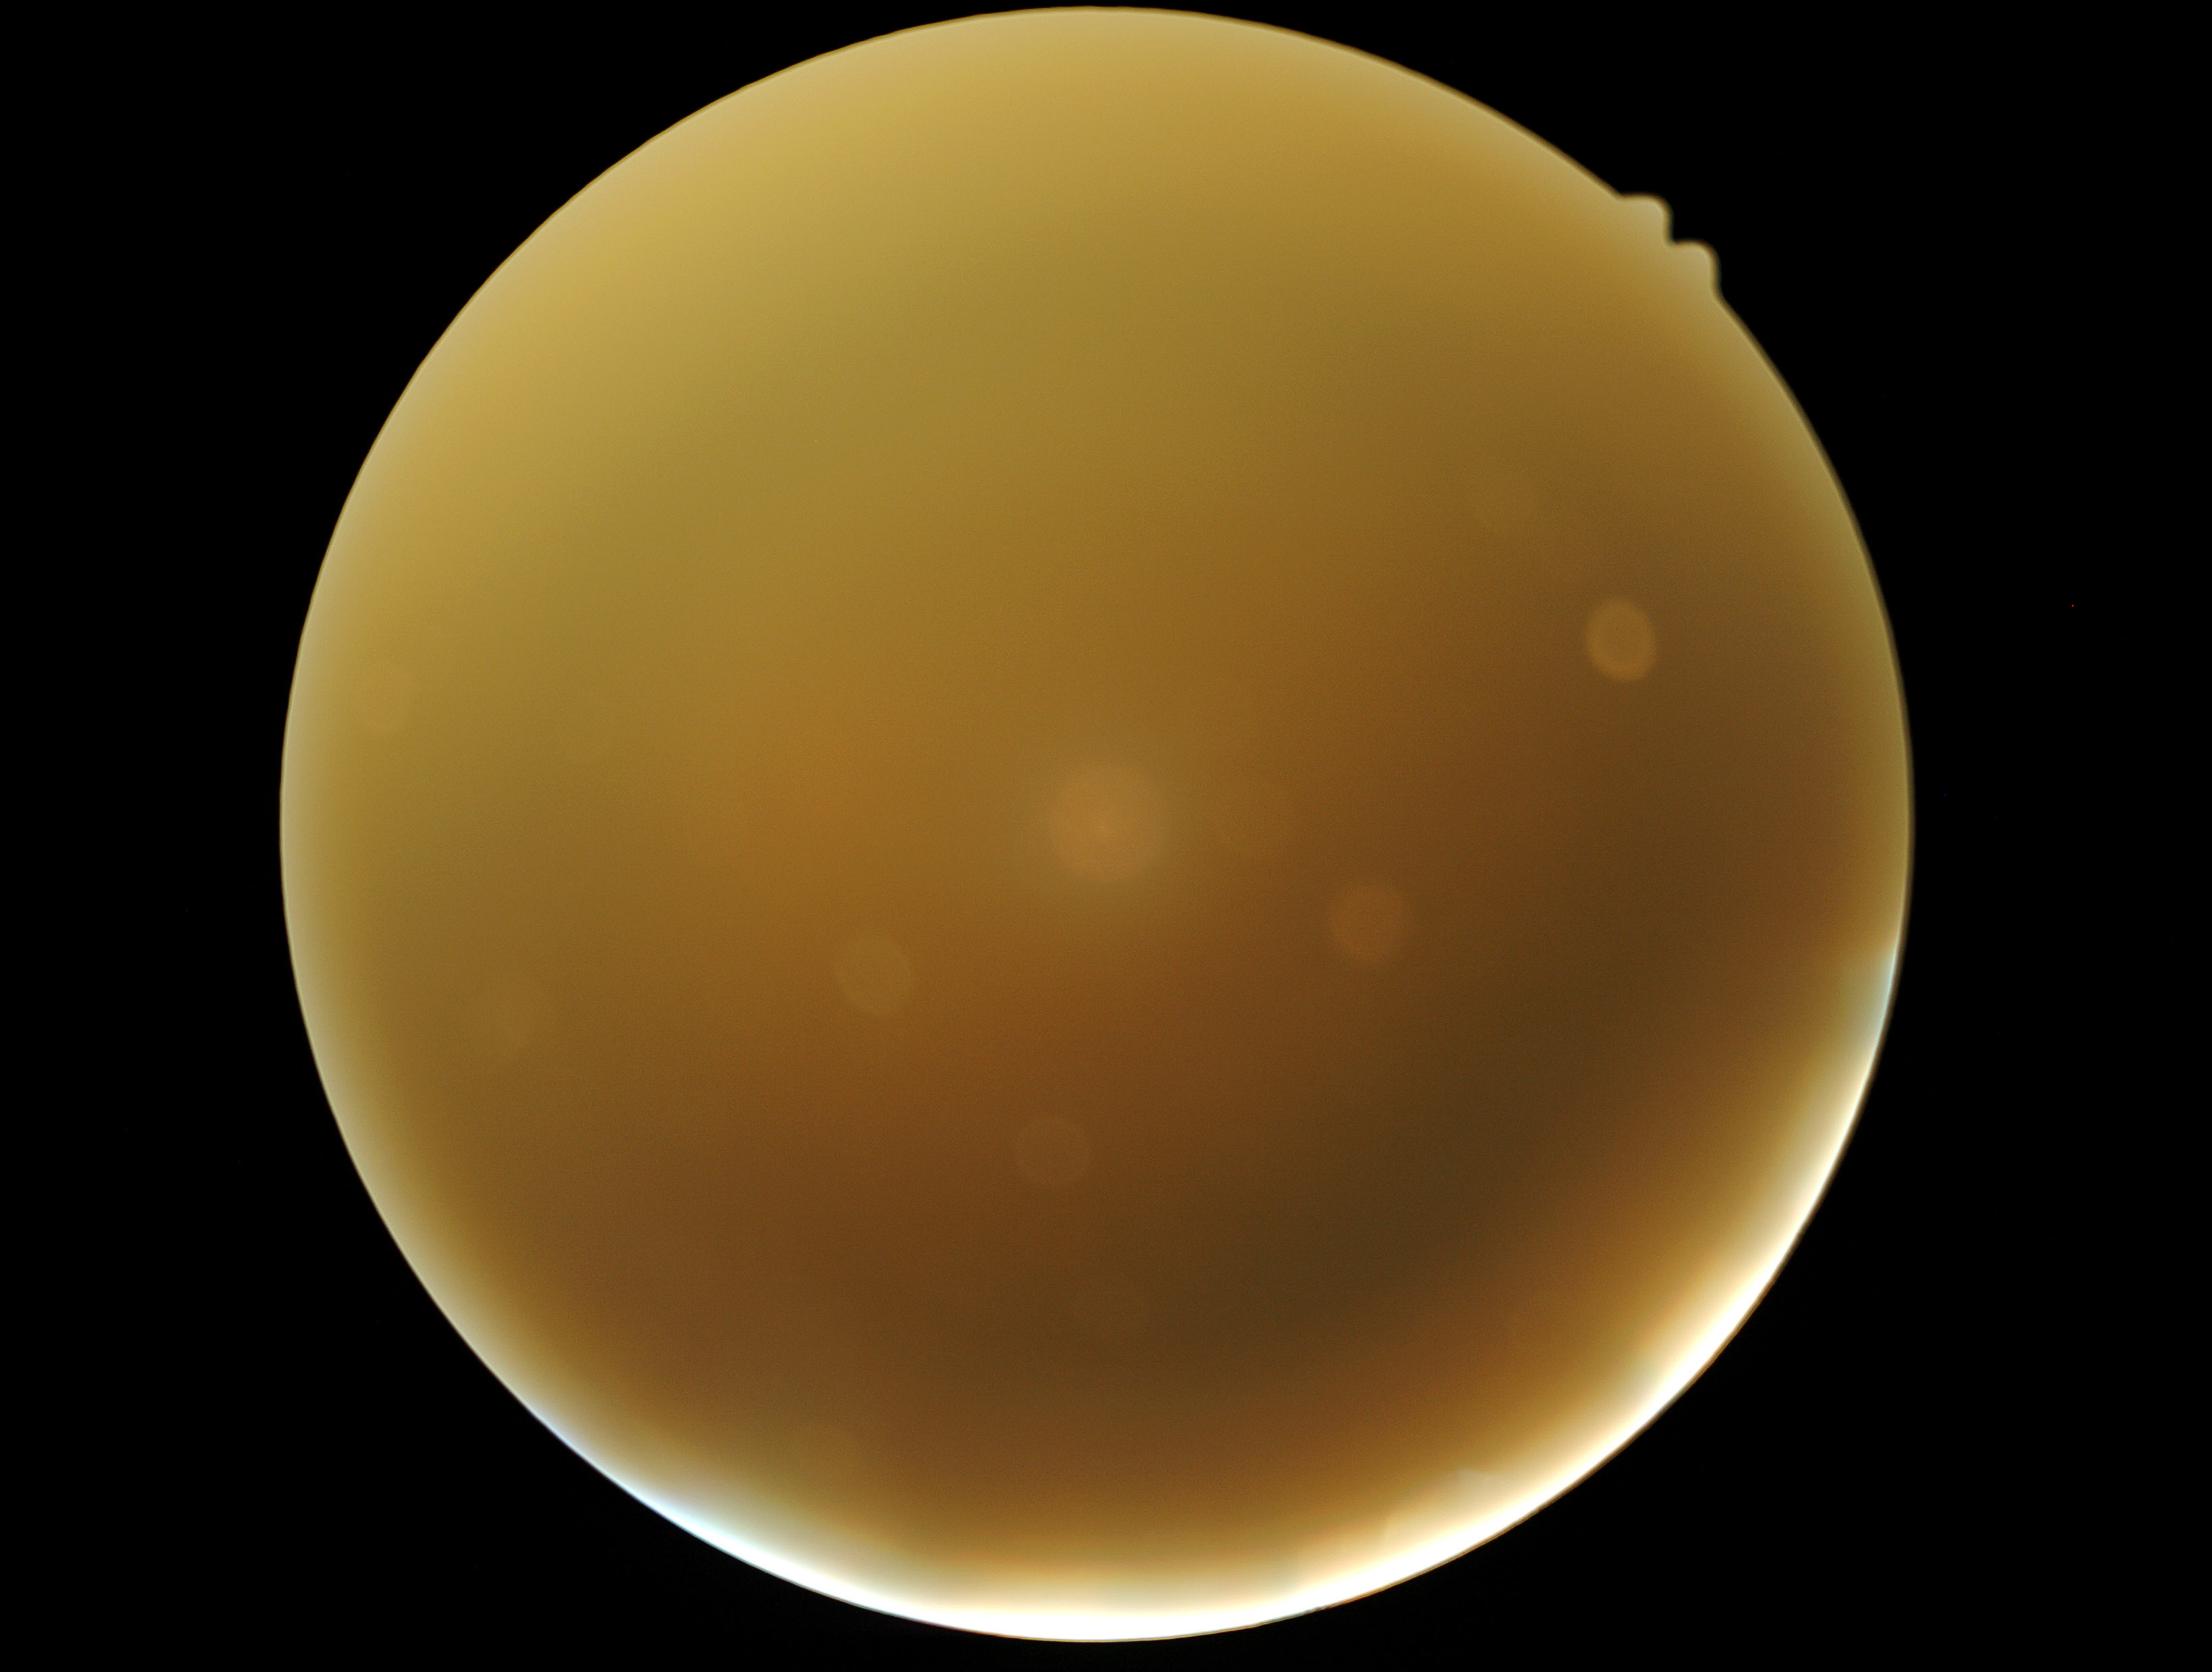
Quality too poor to assess for DR. DR severity is ungradable.